Sex: M · intraocular pressure (non-contact tonometry): 22 mmHg · 43 years old · captured without pupil dilation · refraction: sphere +1.5 D, cylinder -0.25 D, axis 62° · corneal thickness 608 µm: 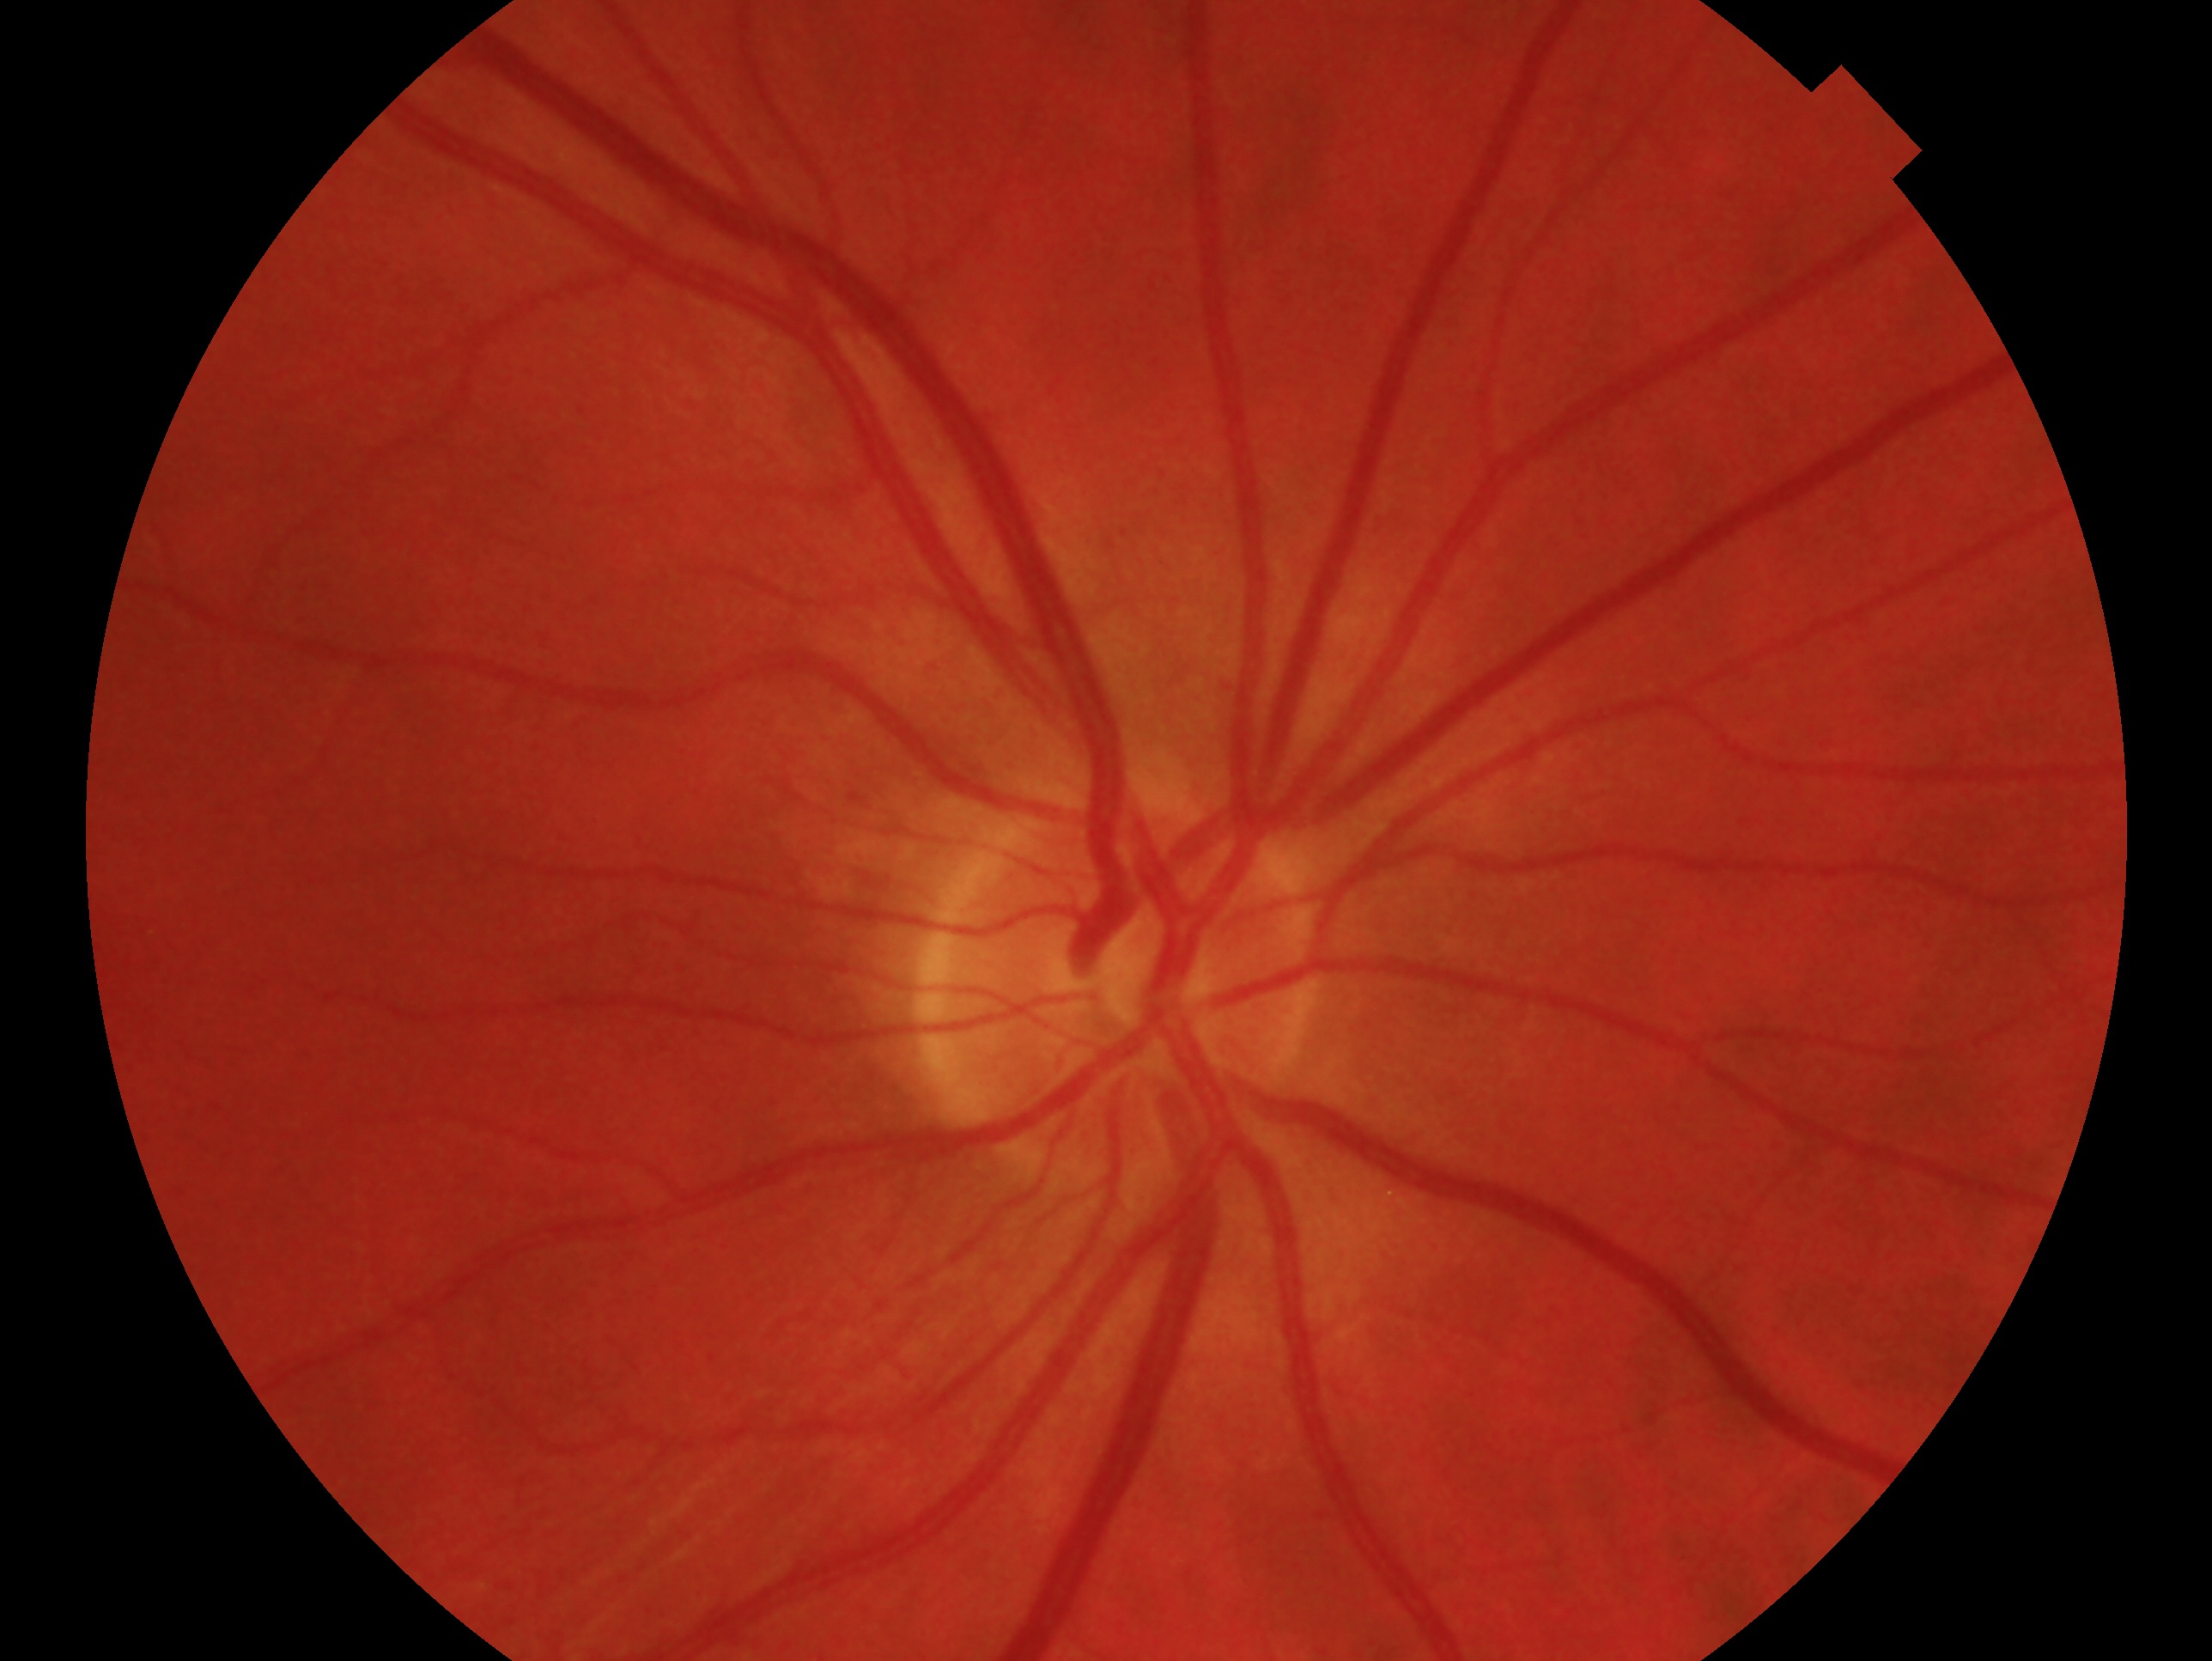 This is the right eye.
Glaucoma diagnosis: negative for glaucoma.